Modified Davis grading:
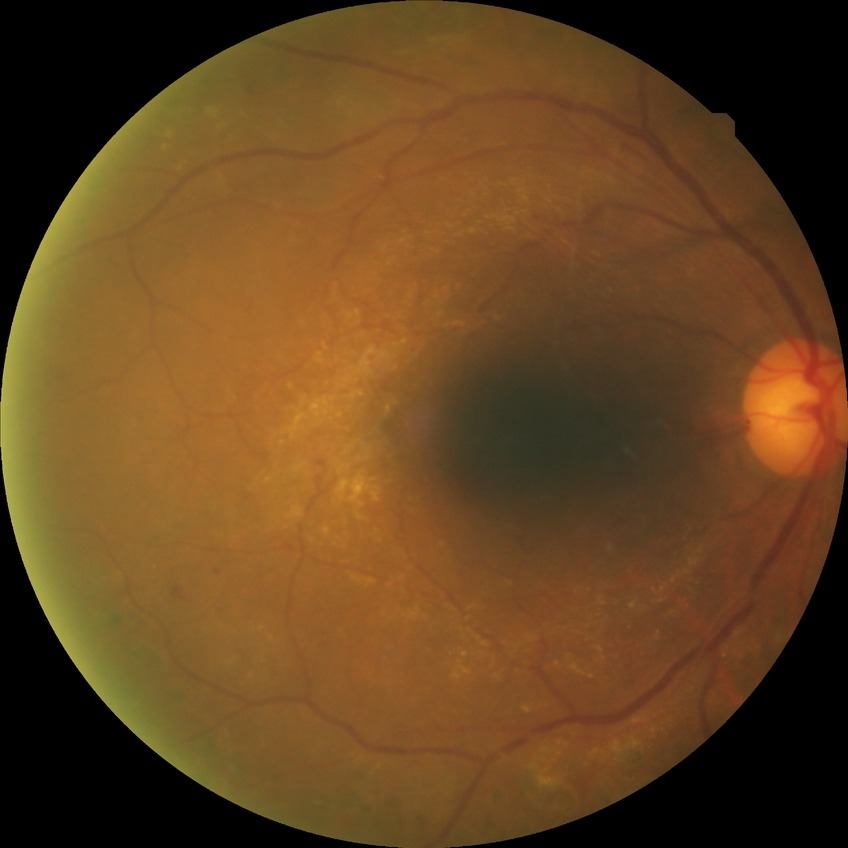 Diabetic retinopathy (DR) is PDR (proliferative diabetic retinopathy).